Color fundus image; Nidek AFC-330:
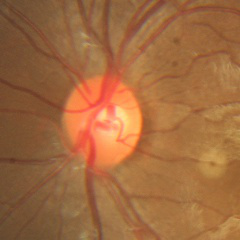
Impression = no evidence of glaucoma.